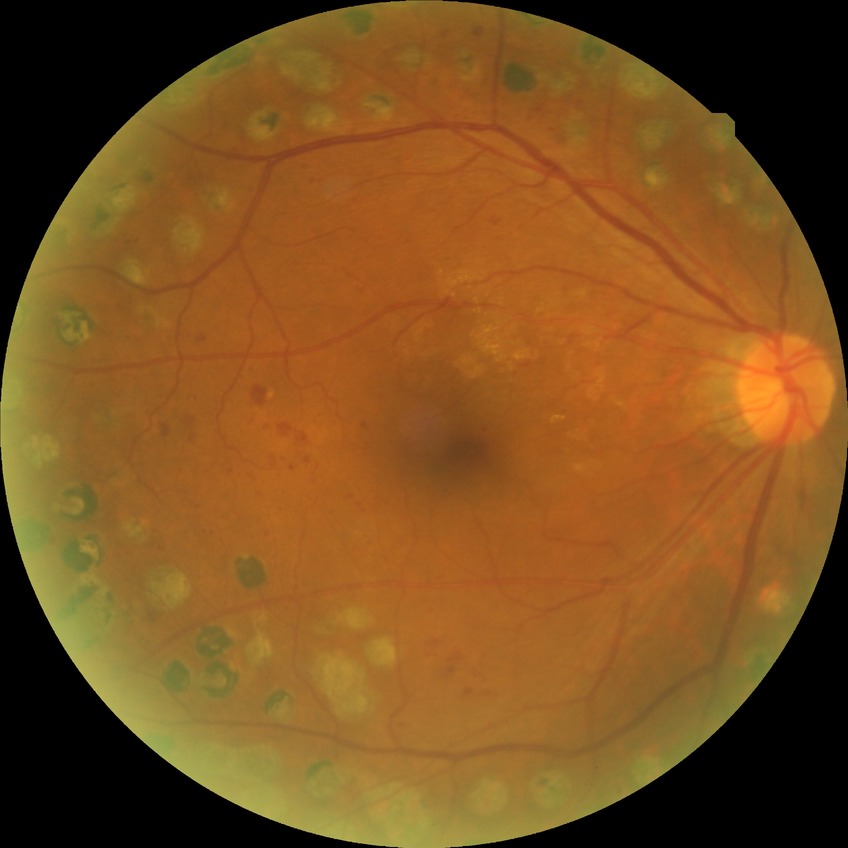
DR severity is PDR.